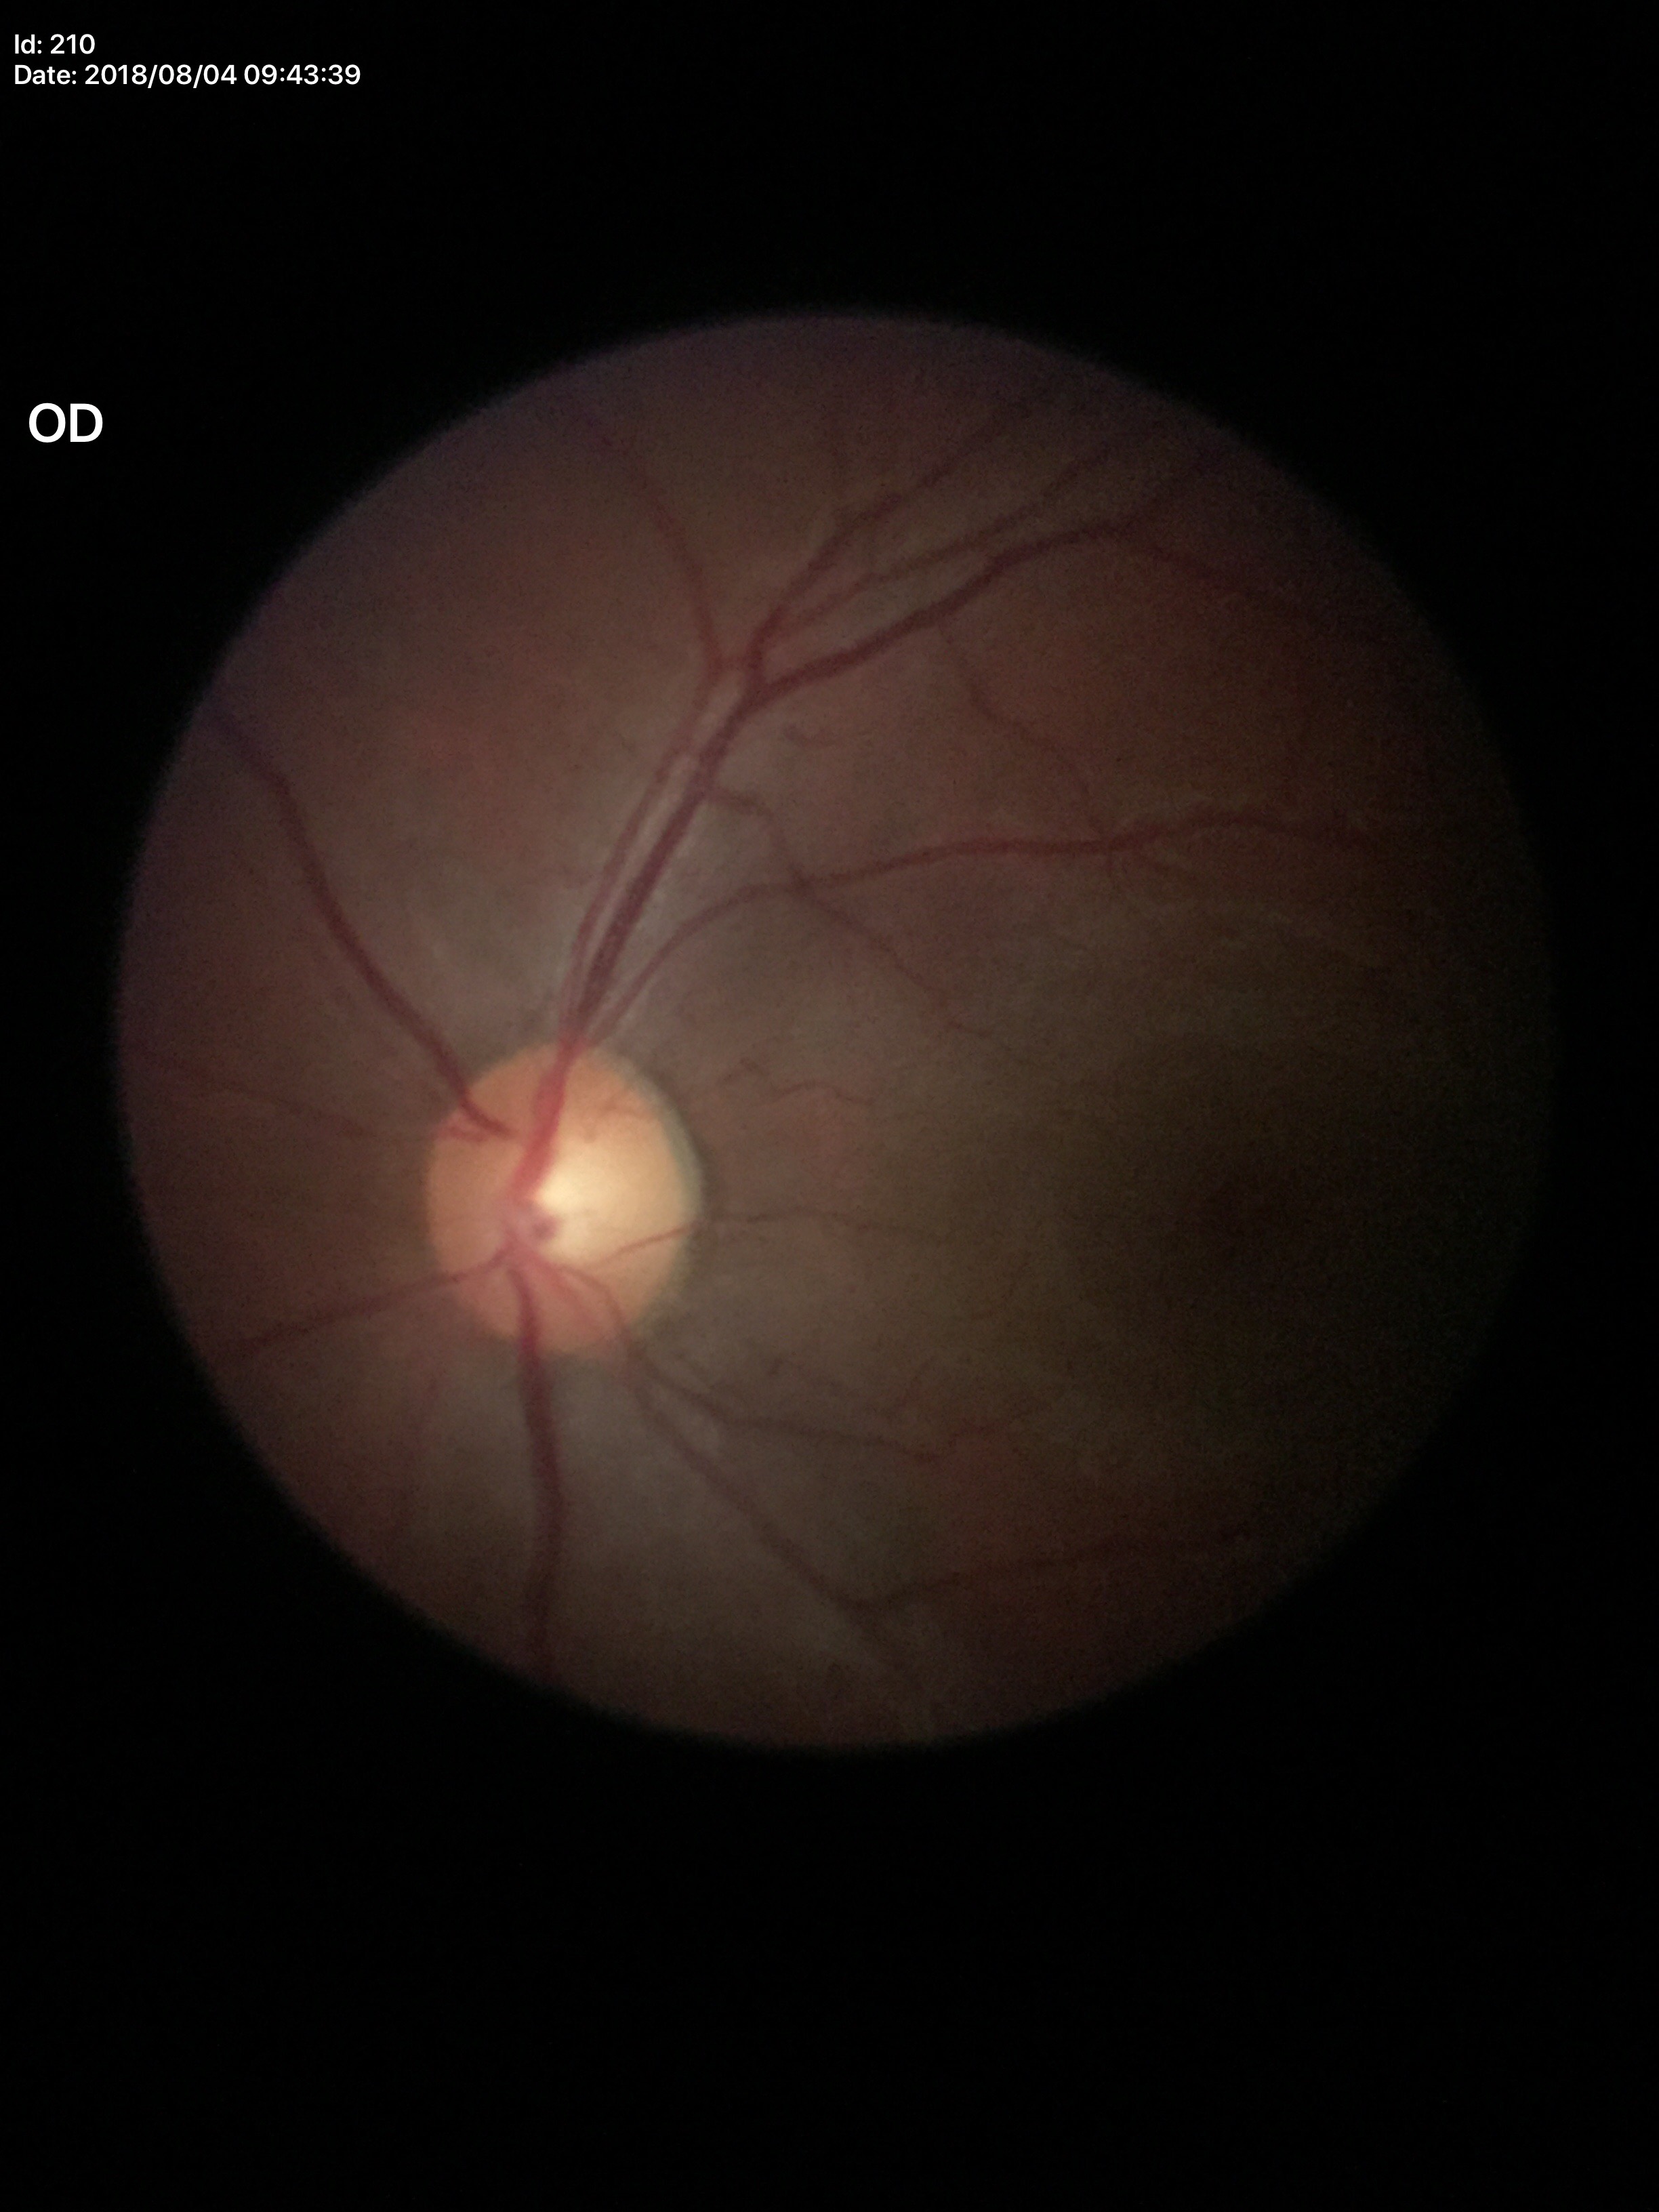
{
  "glaucoma_decision": "not suspect",
  "vcdr": "0.55",
  "hcdr": "0.57"
}